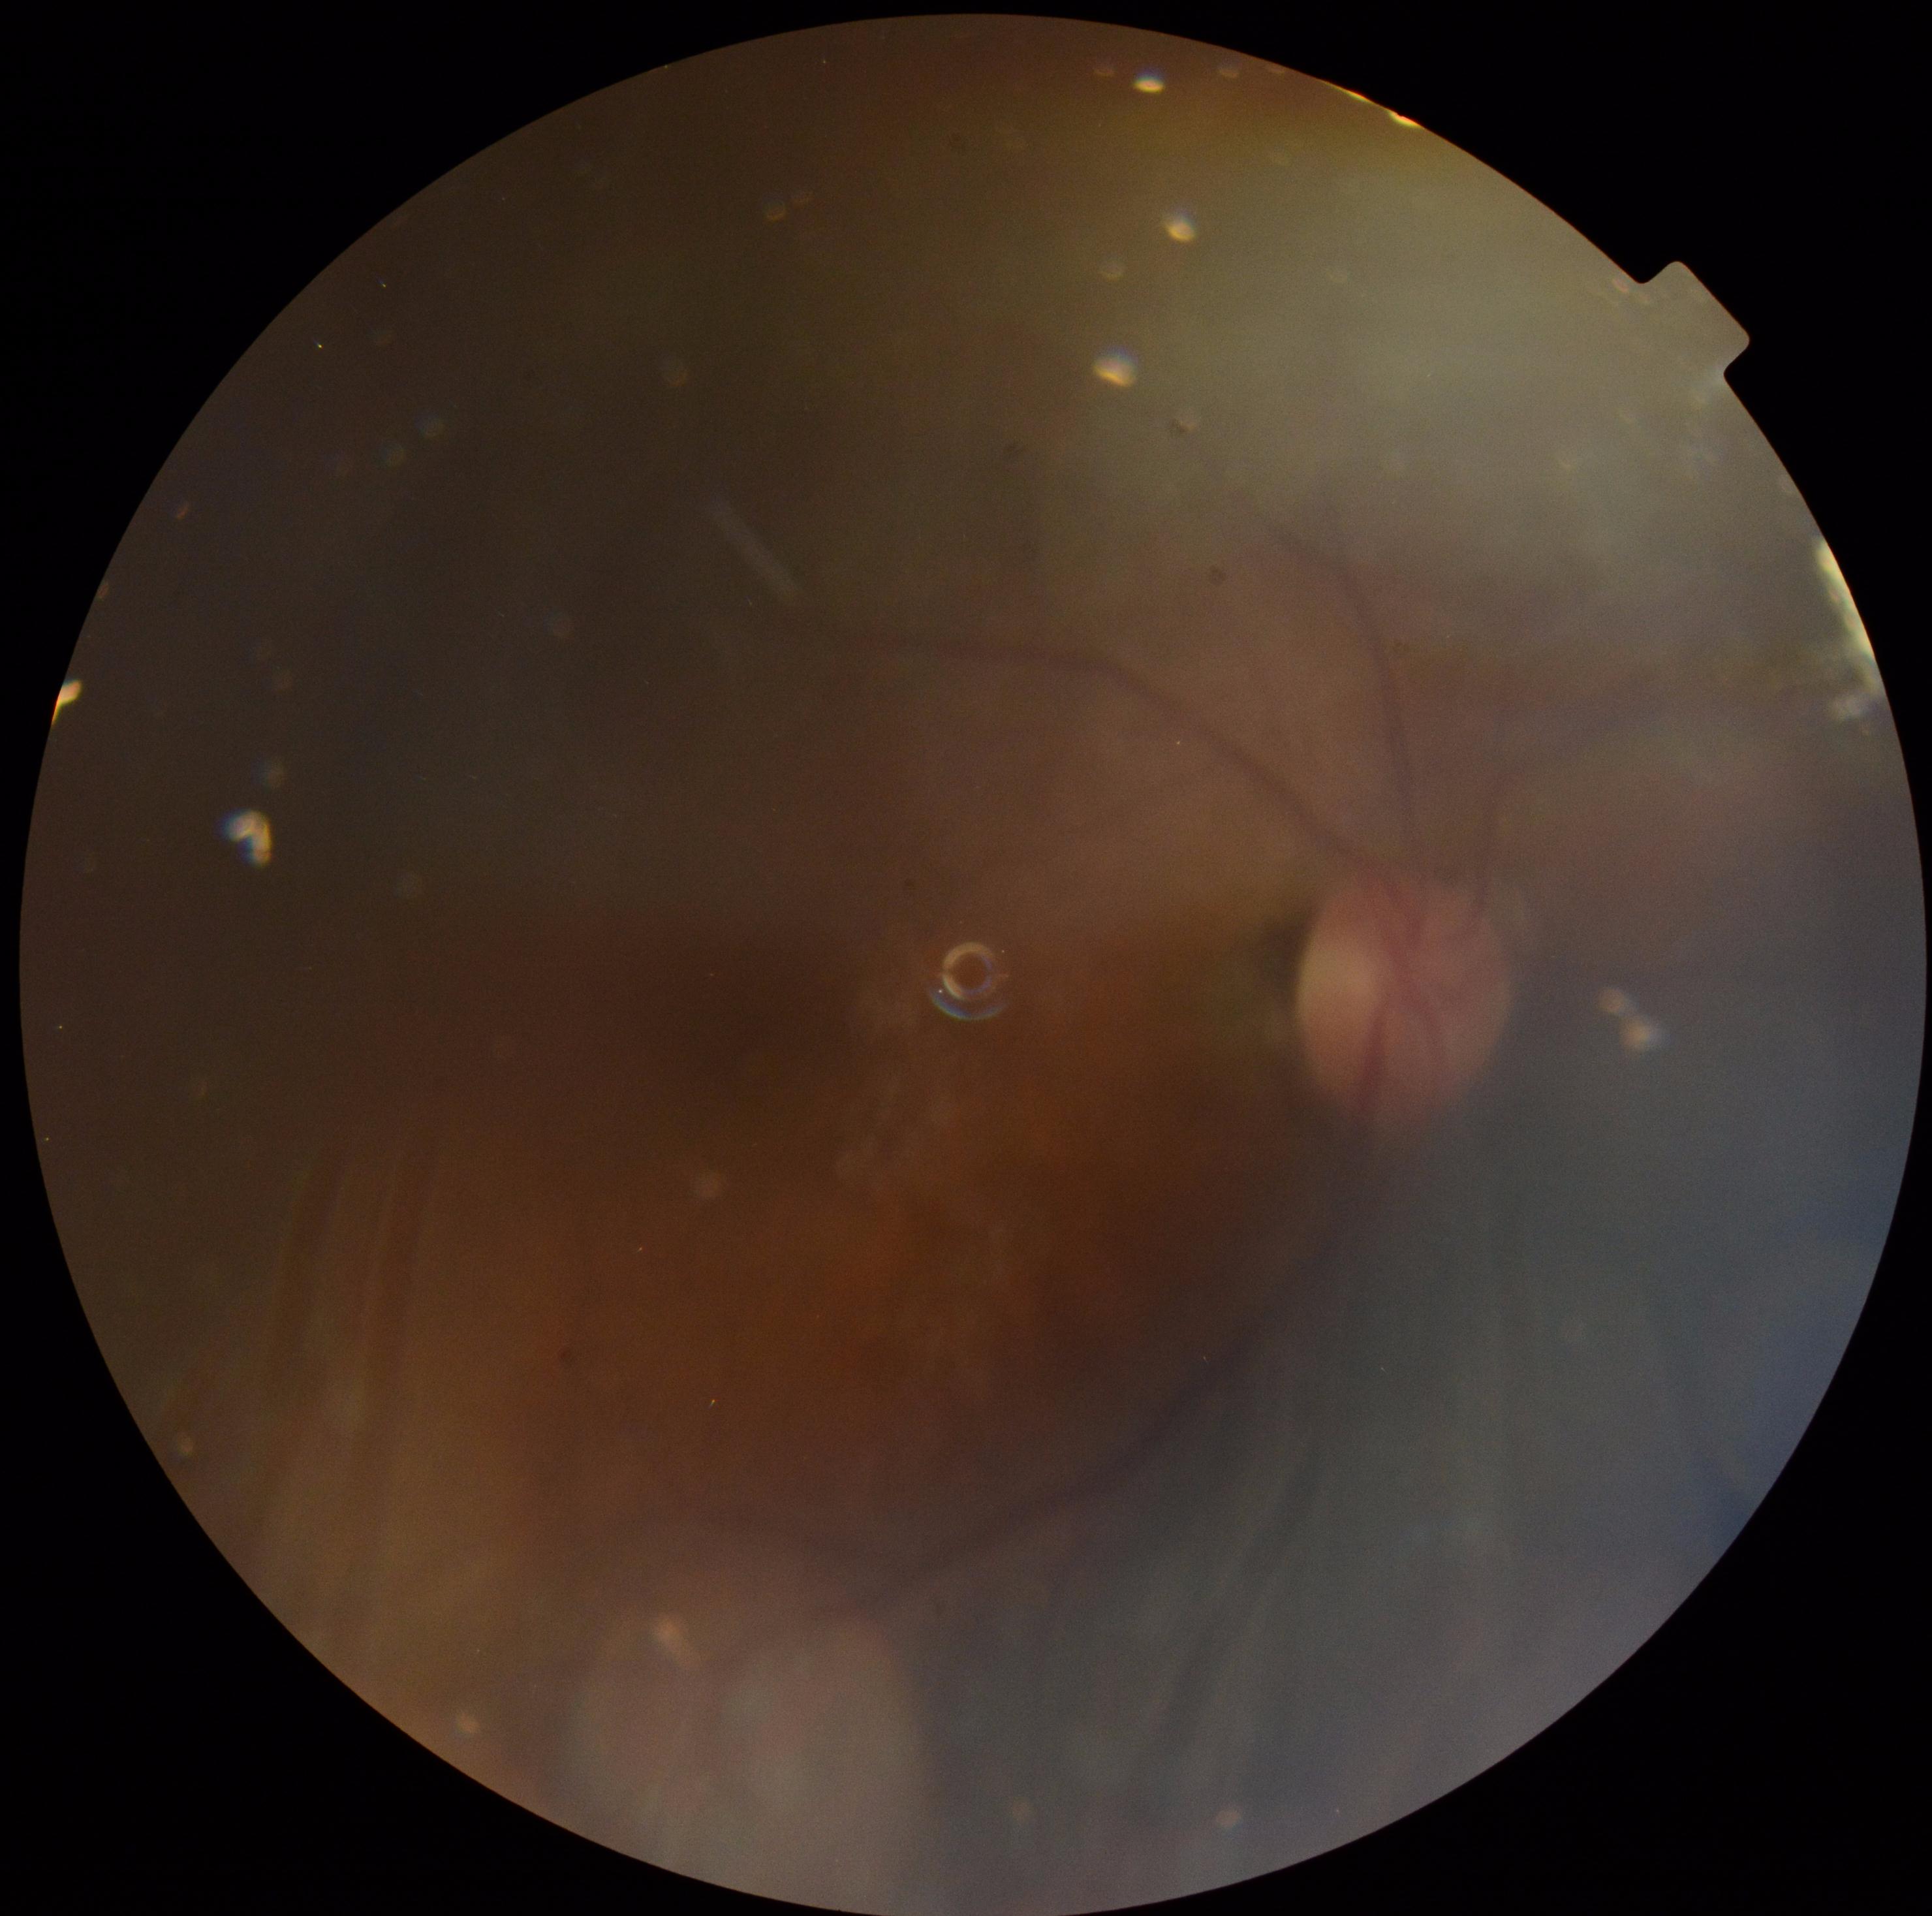
{"quality": "too poor for DR grading", "dr_grade": "ungradable"}